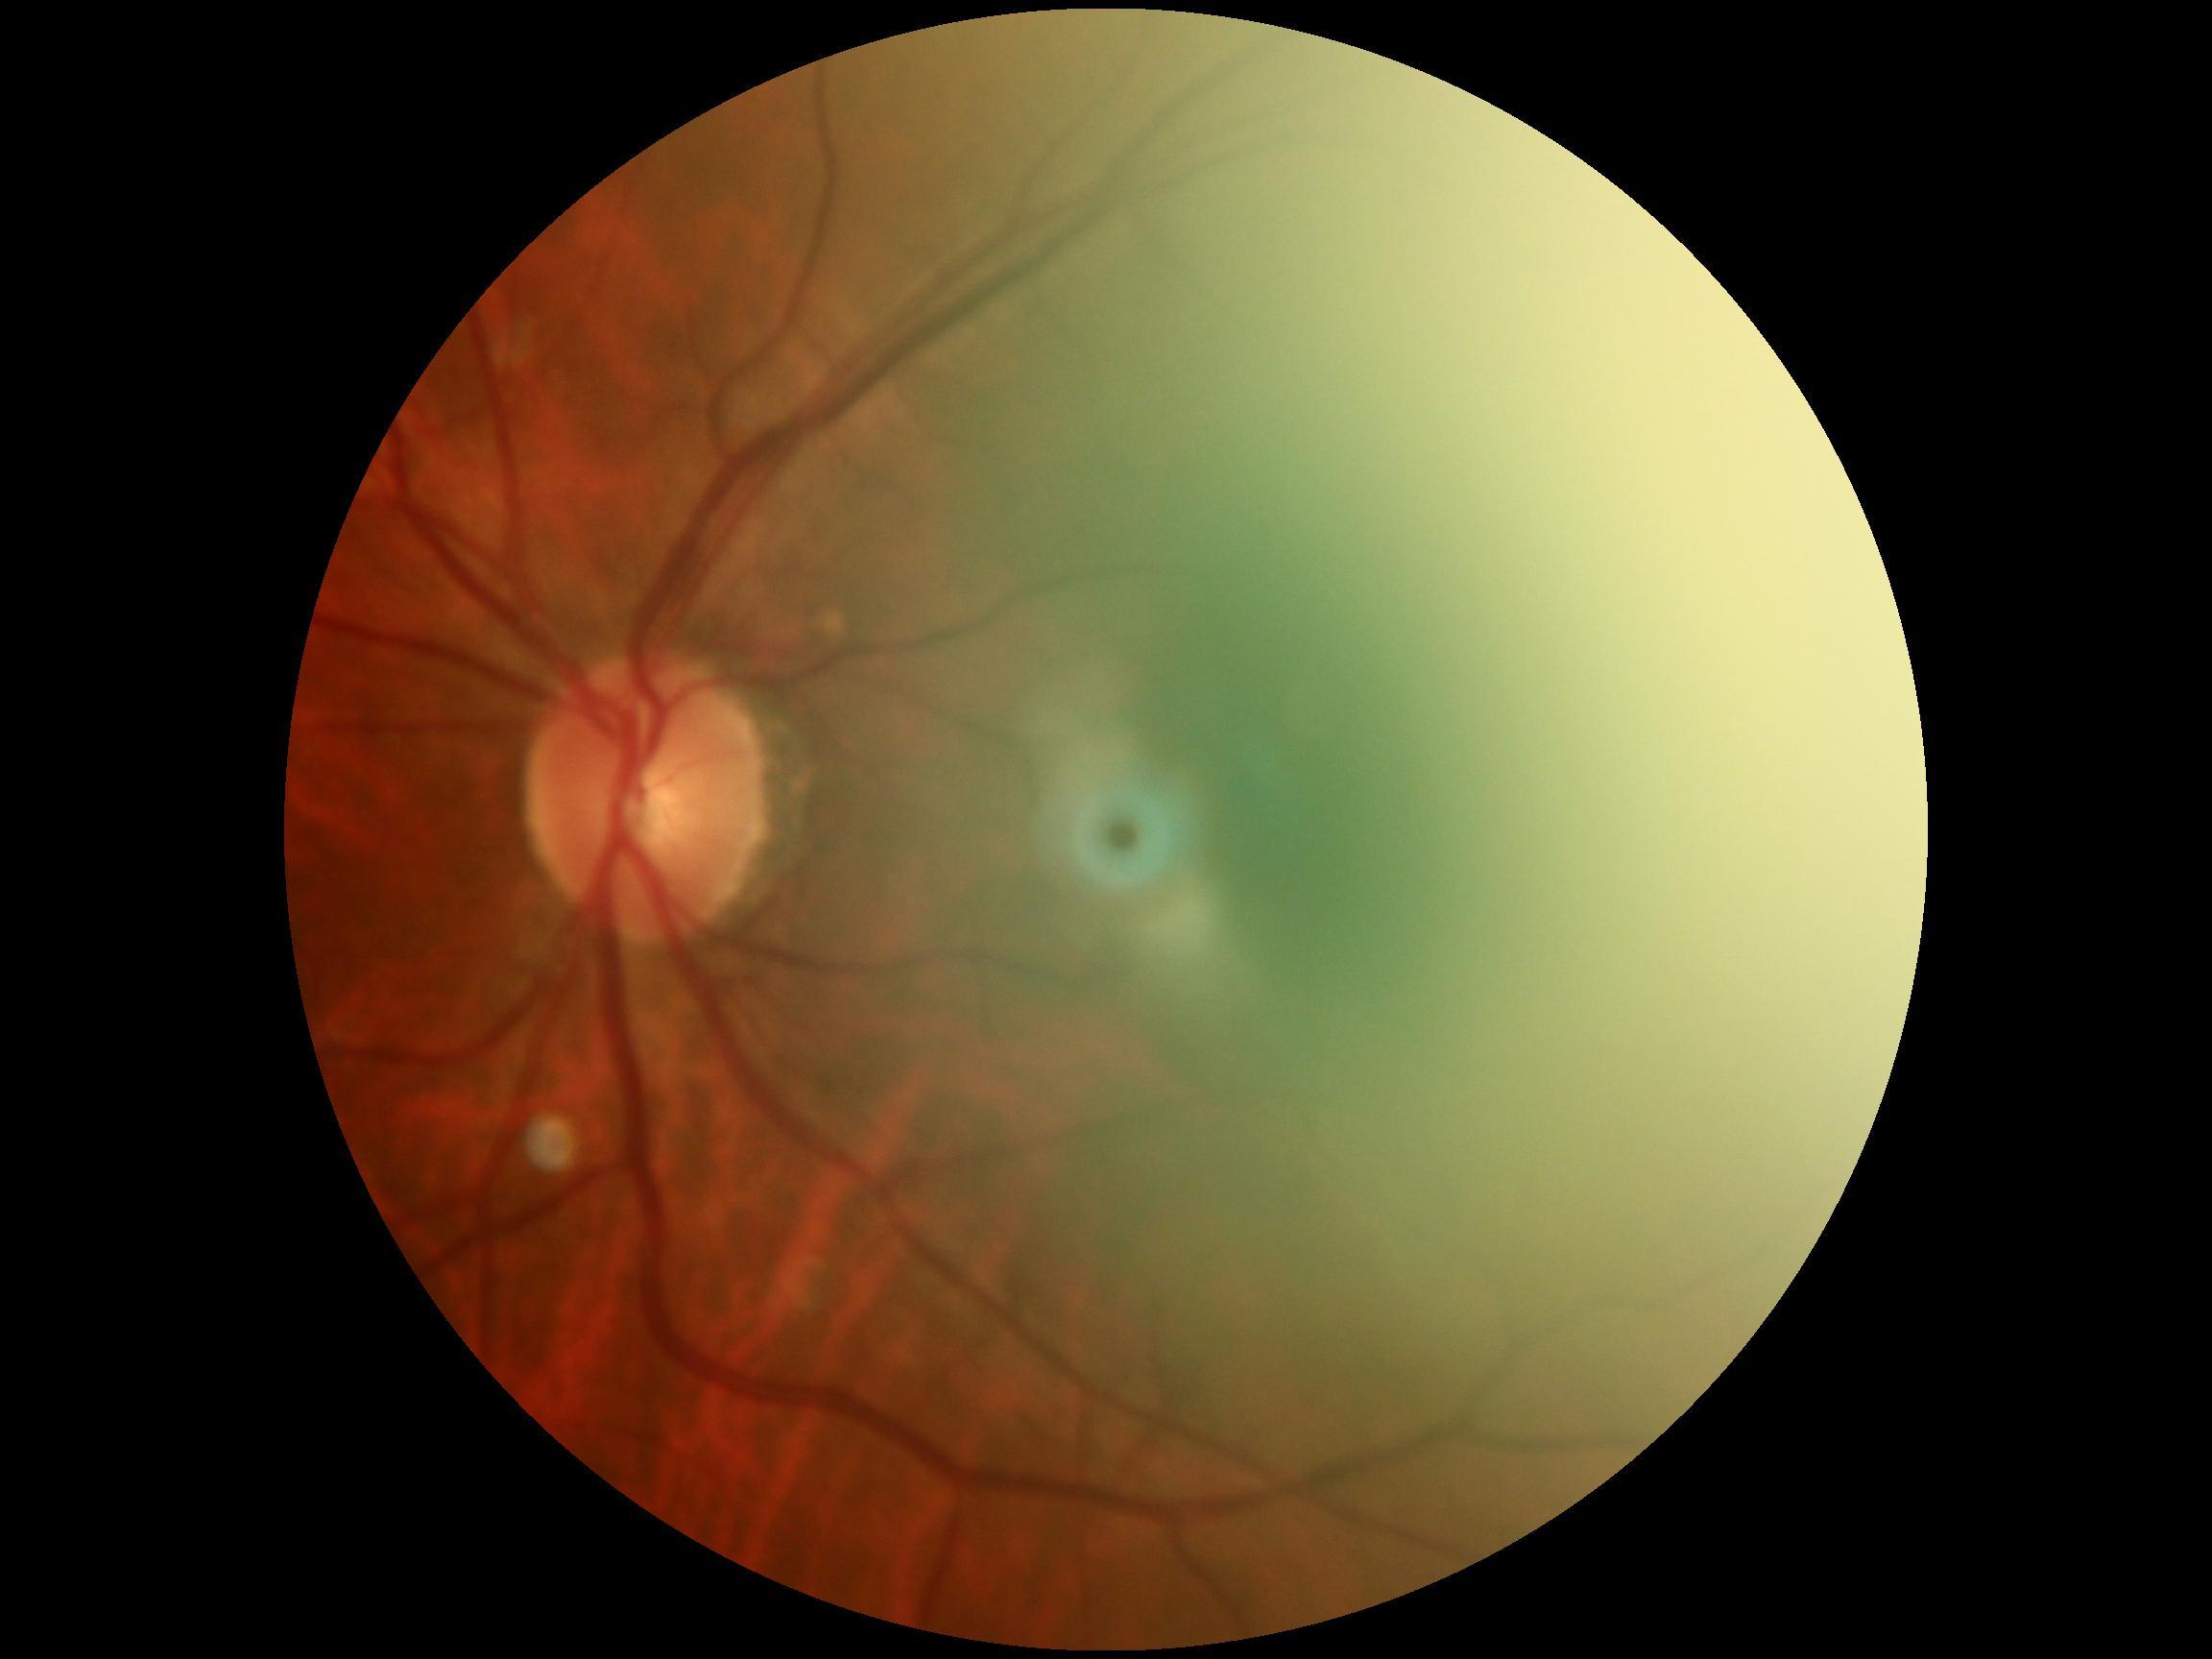

– DR severity — no apparent diabetic retinopathy (grade 0)